Color fundus photograph. Image size 2048x1536:
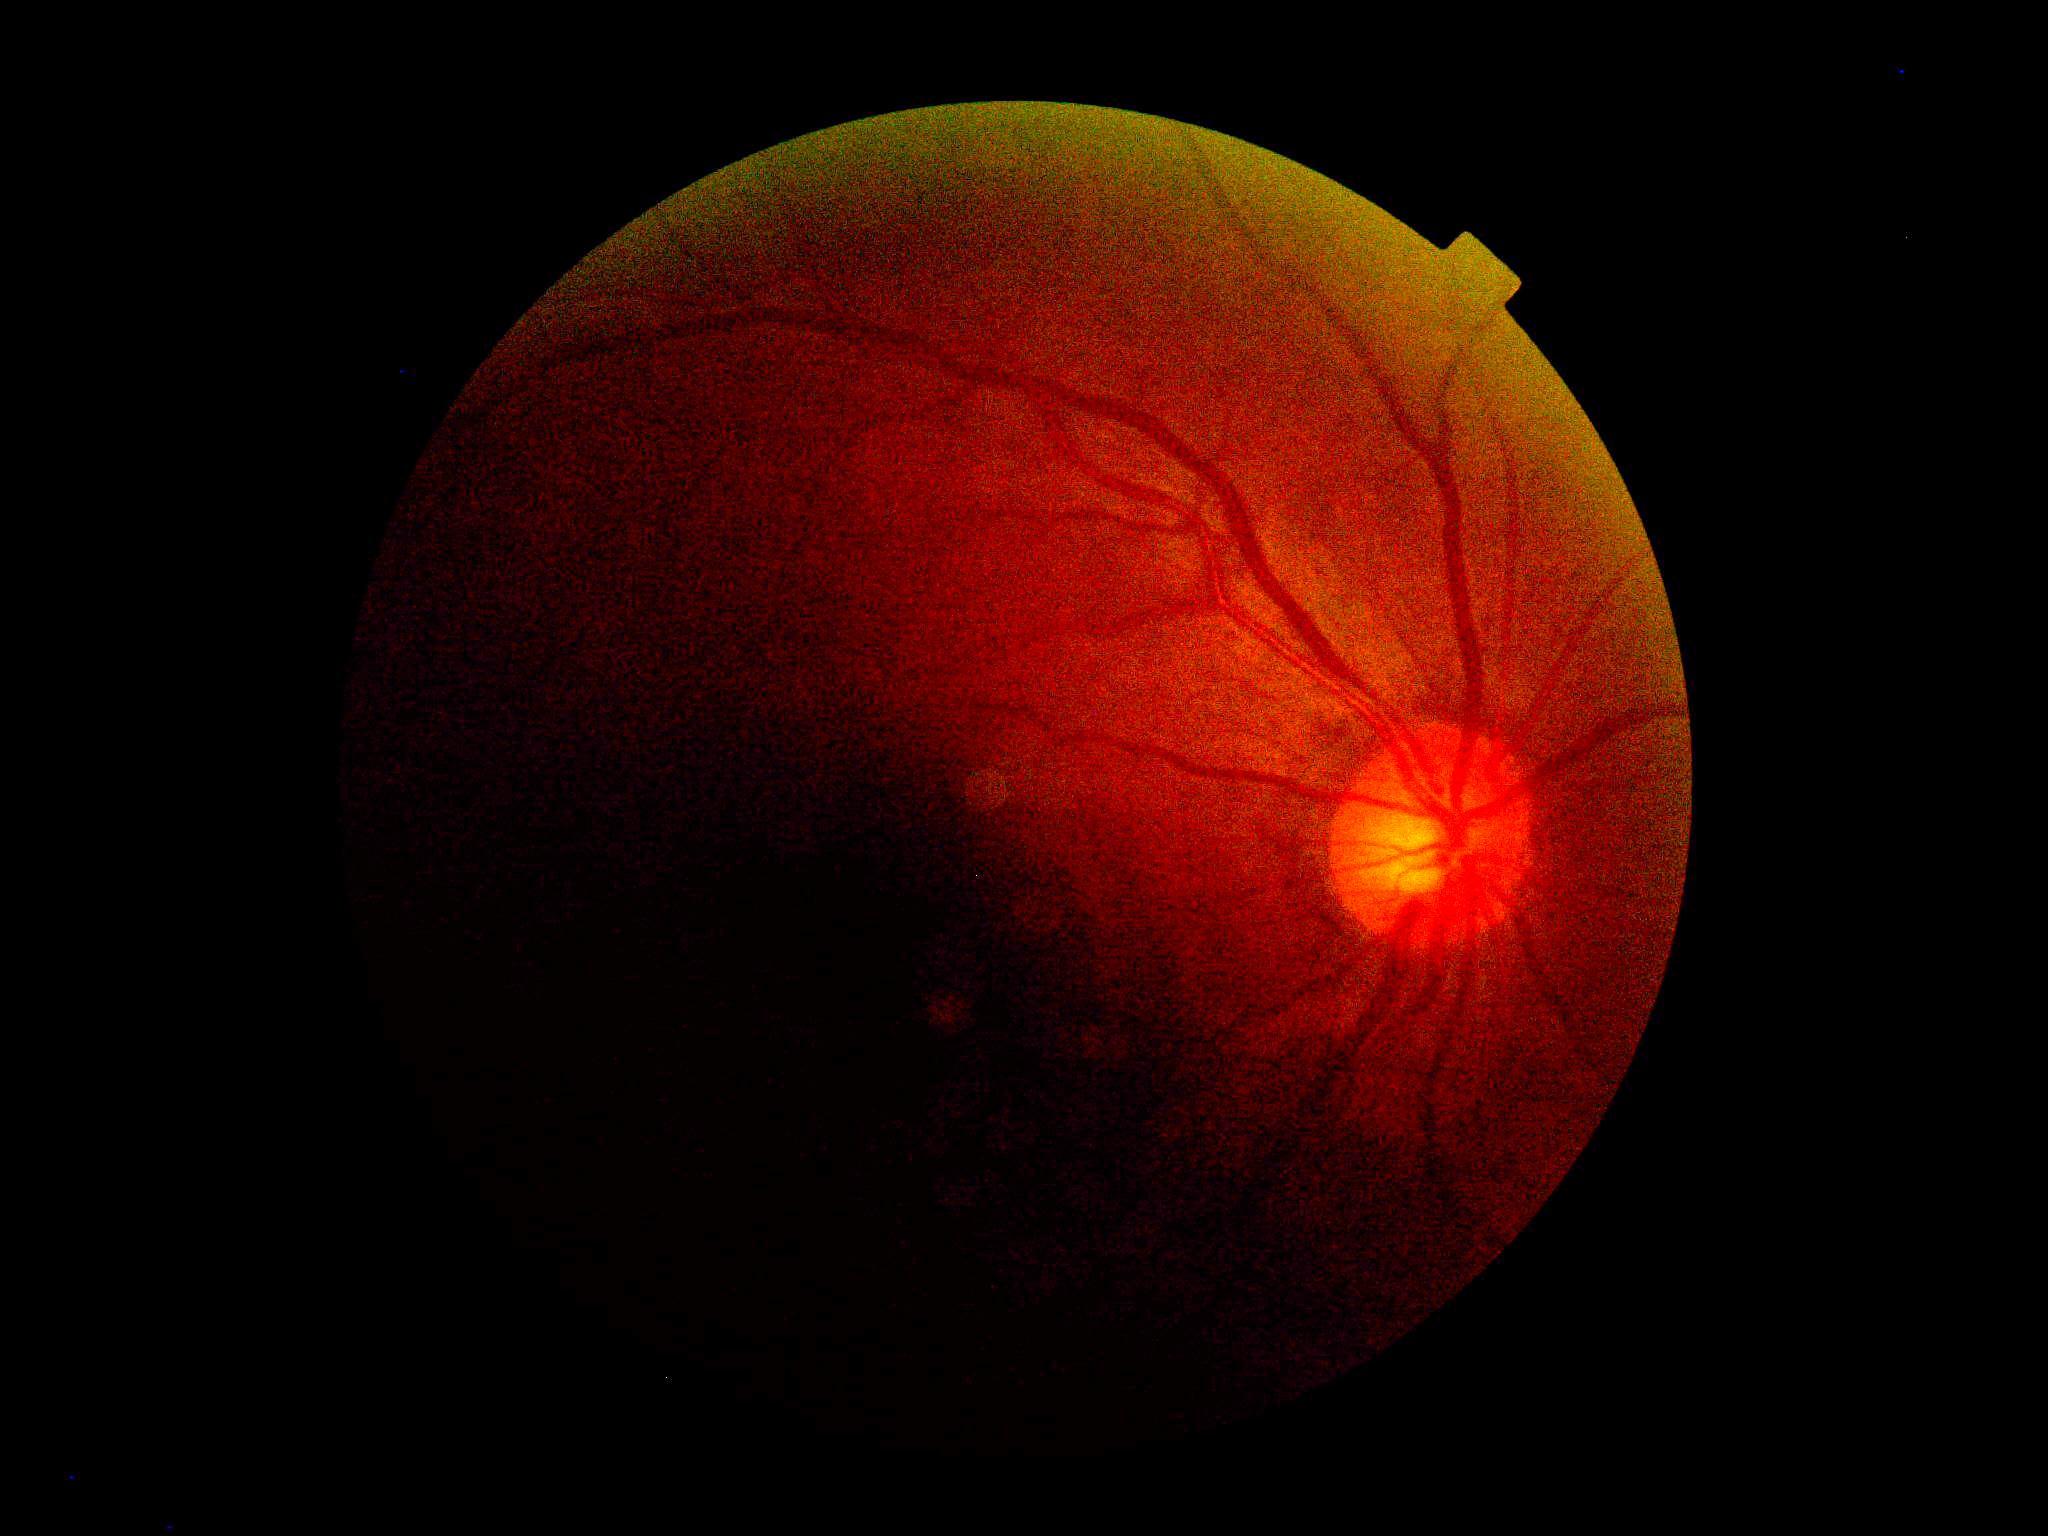
diabetic retinopathy grade@ungradable; image quality@below grading threshold.